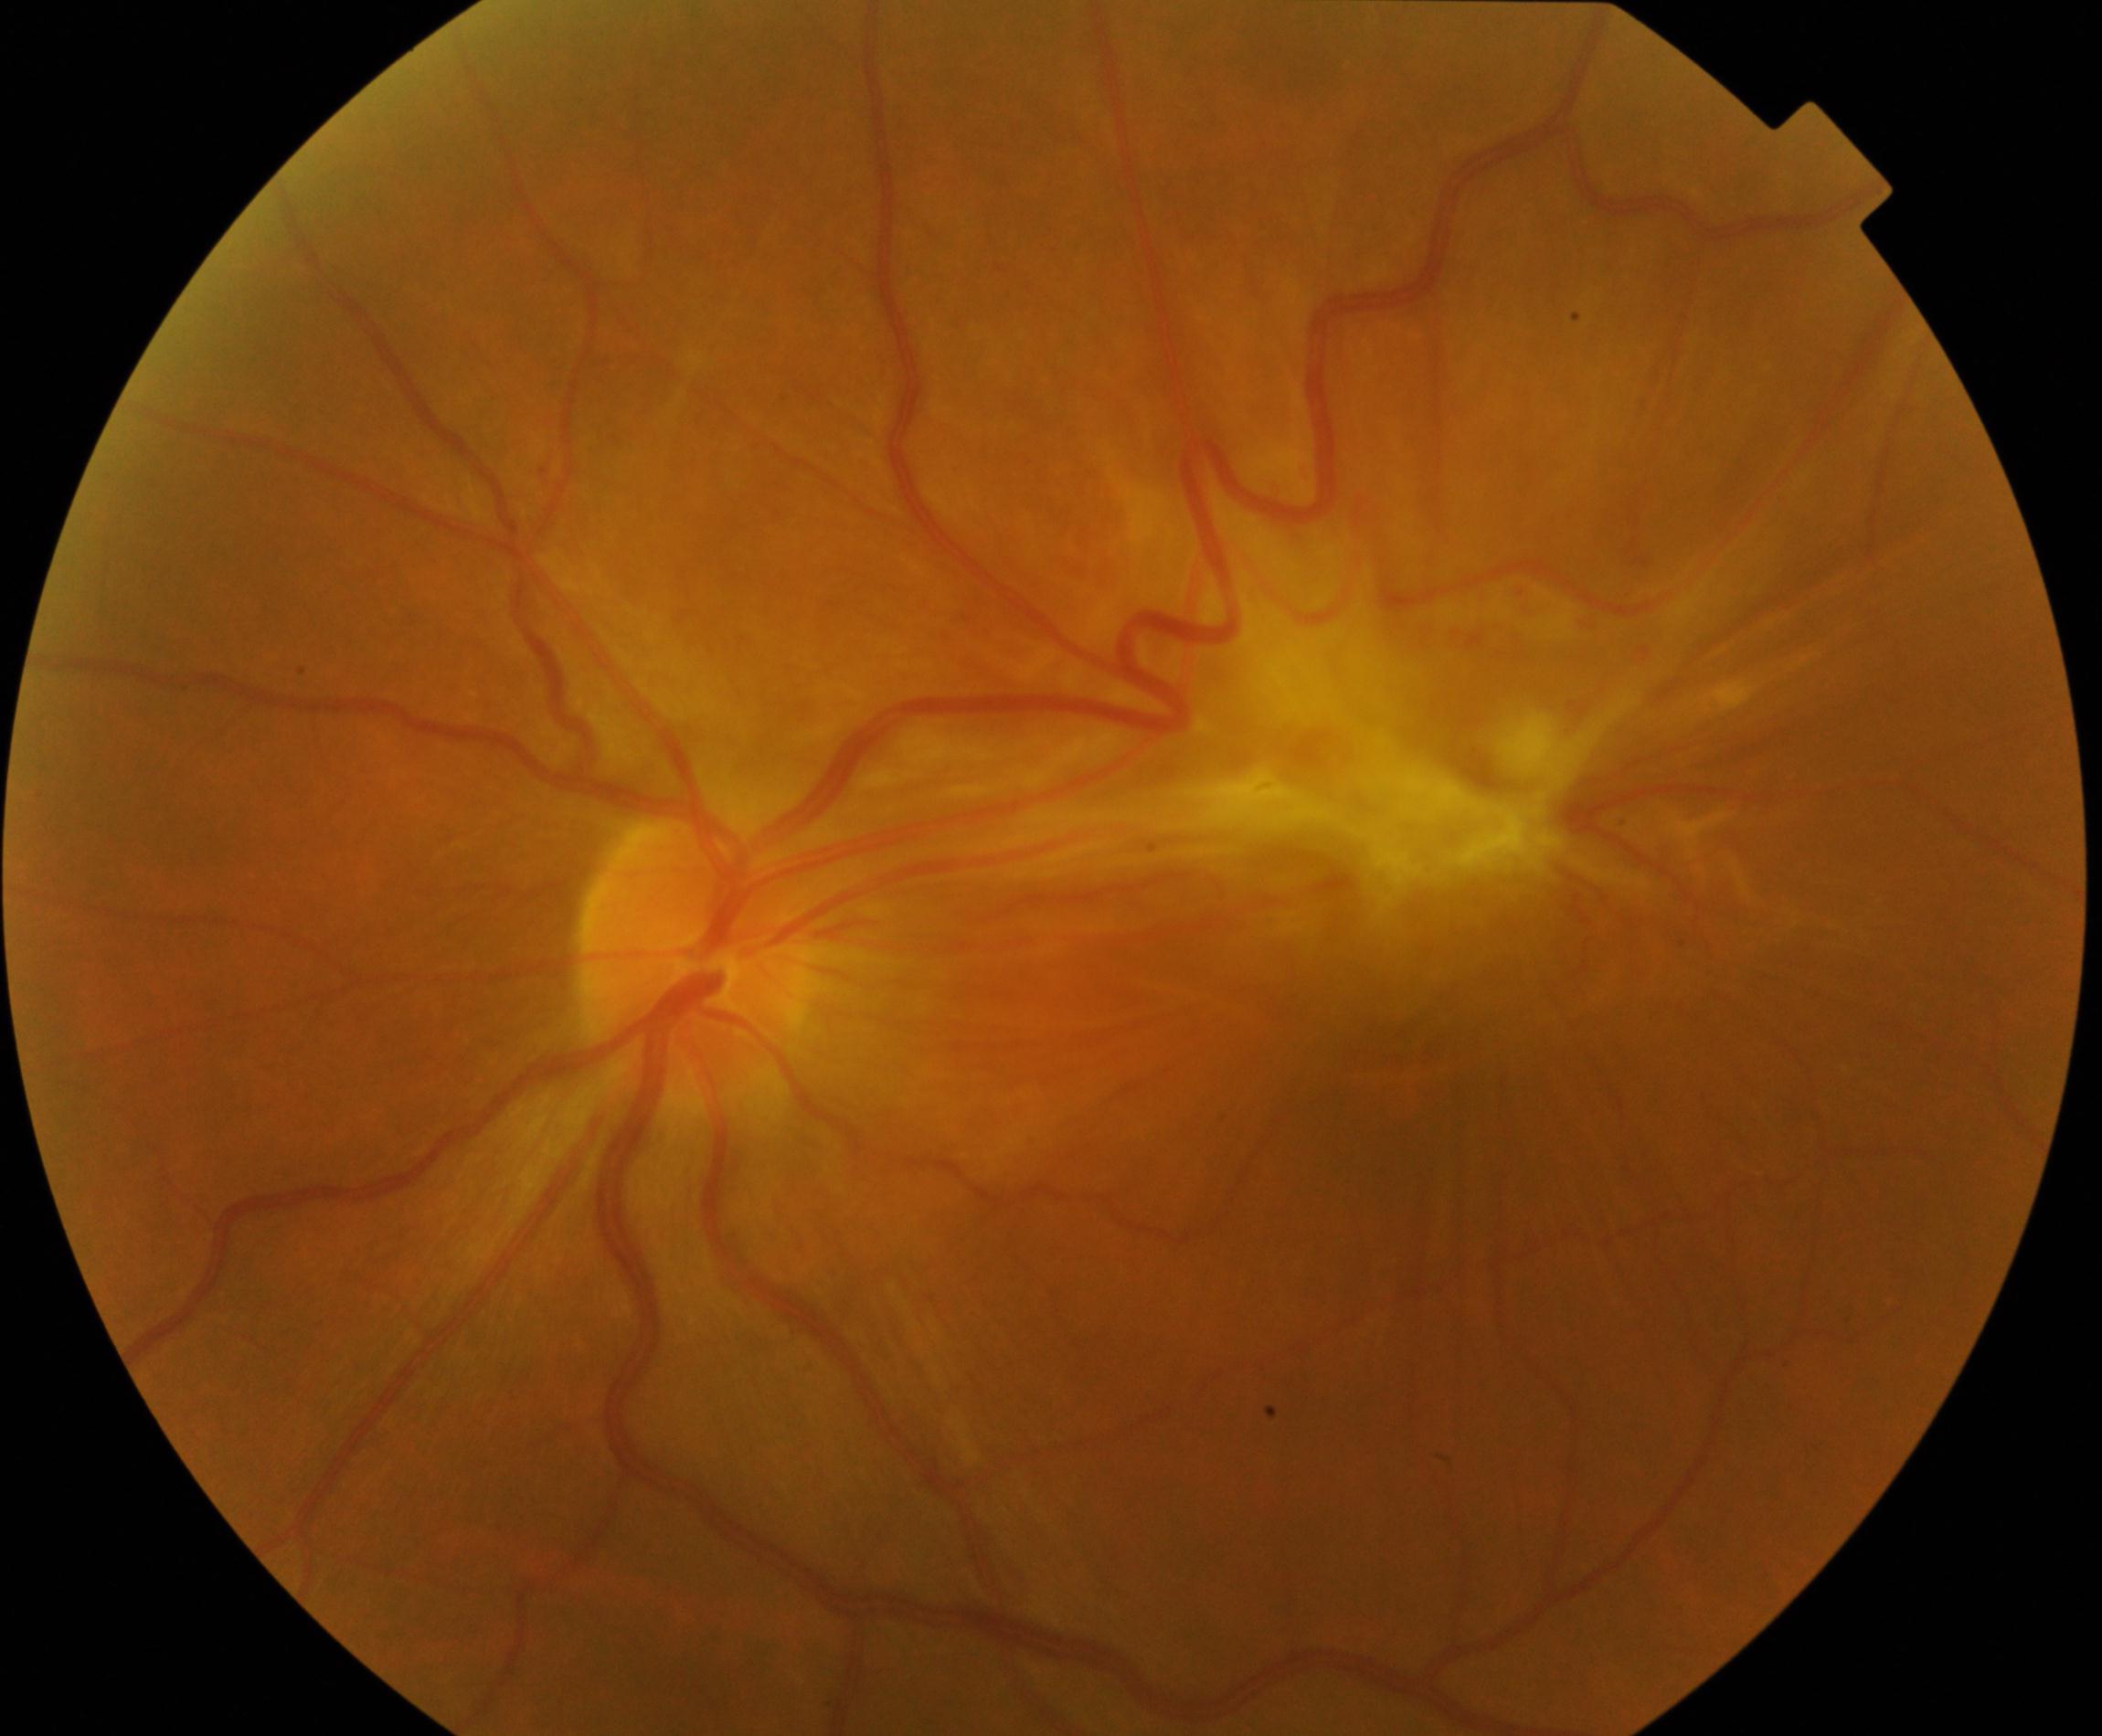
Findings: fibrosis.